Modified Davis grading:
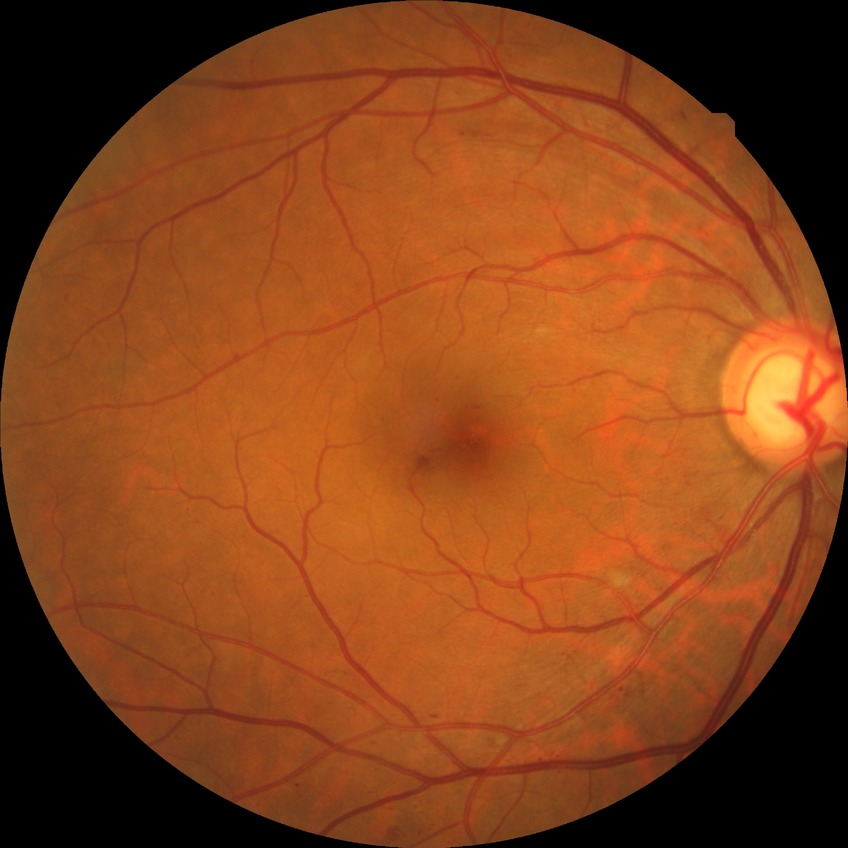 * diabetic retinopathy grade: simple diabetic retinopathy